403x403px; fundus image cropped to the optic disc
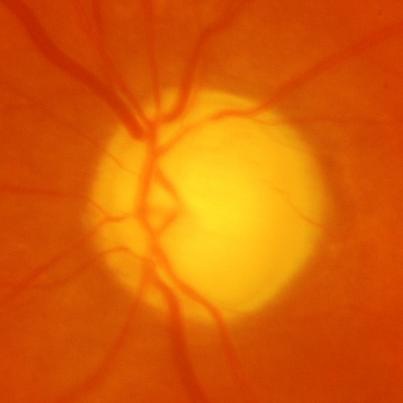
Glaucomatous optic neuropathy is present. Assessment = glaucomatous changes.